Image size 848x848.
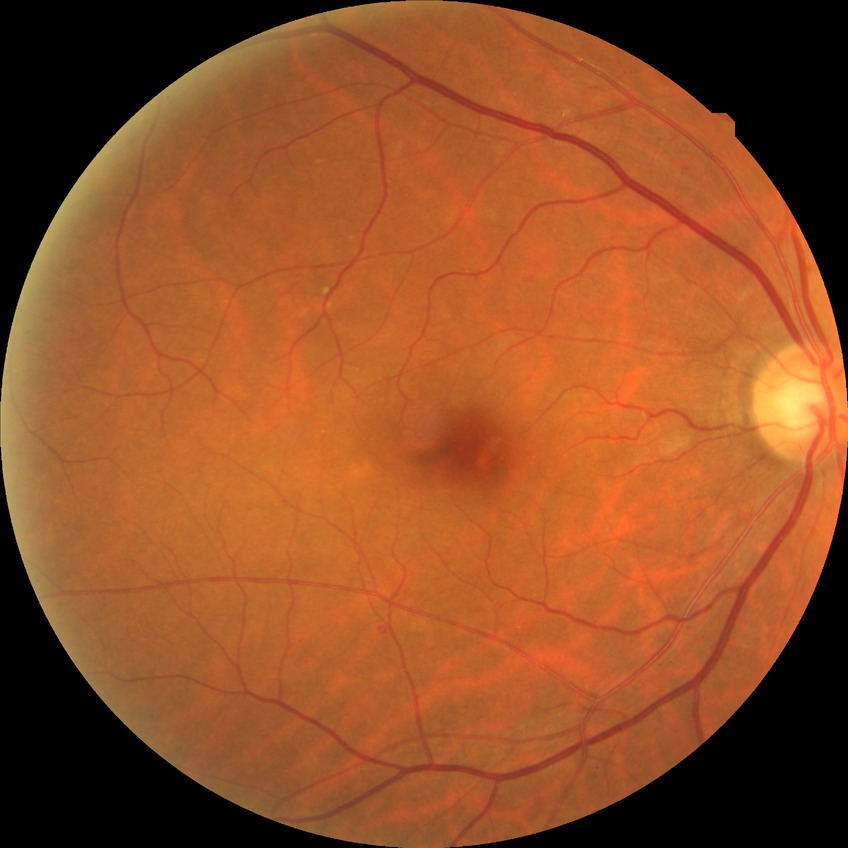

Diabetic retinopathy (DR) is SDR (simple diabetic retinopathy).